Fundus photo — 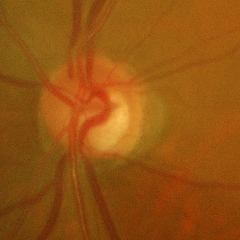 Showing advanced-stage glaucoma.